Retinal fundus photograph: 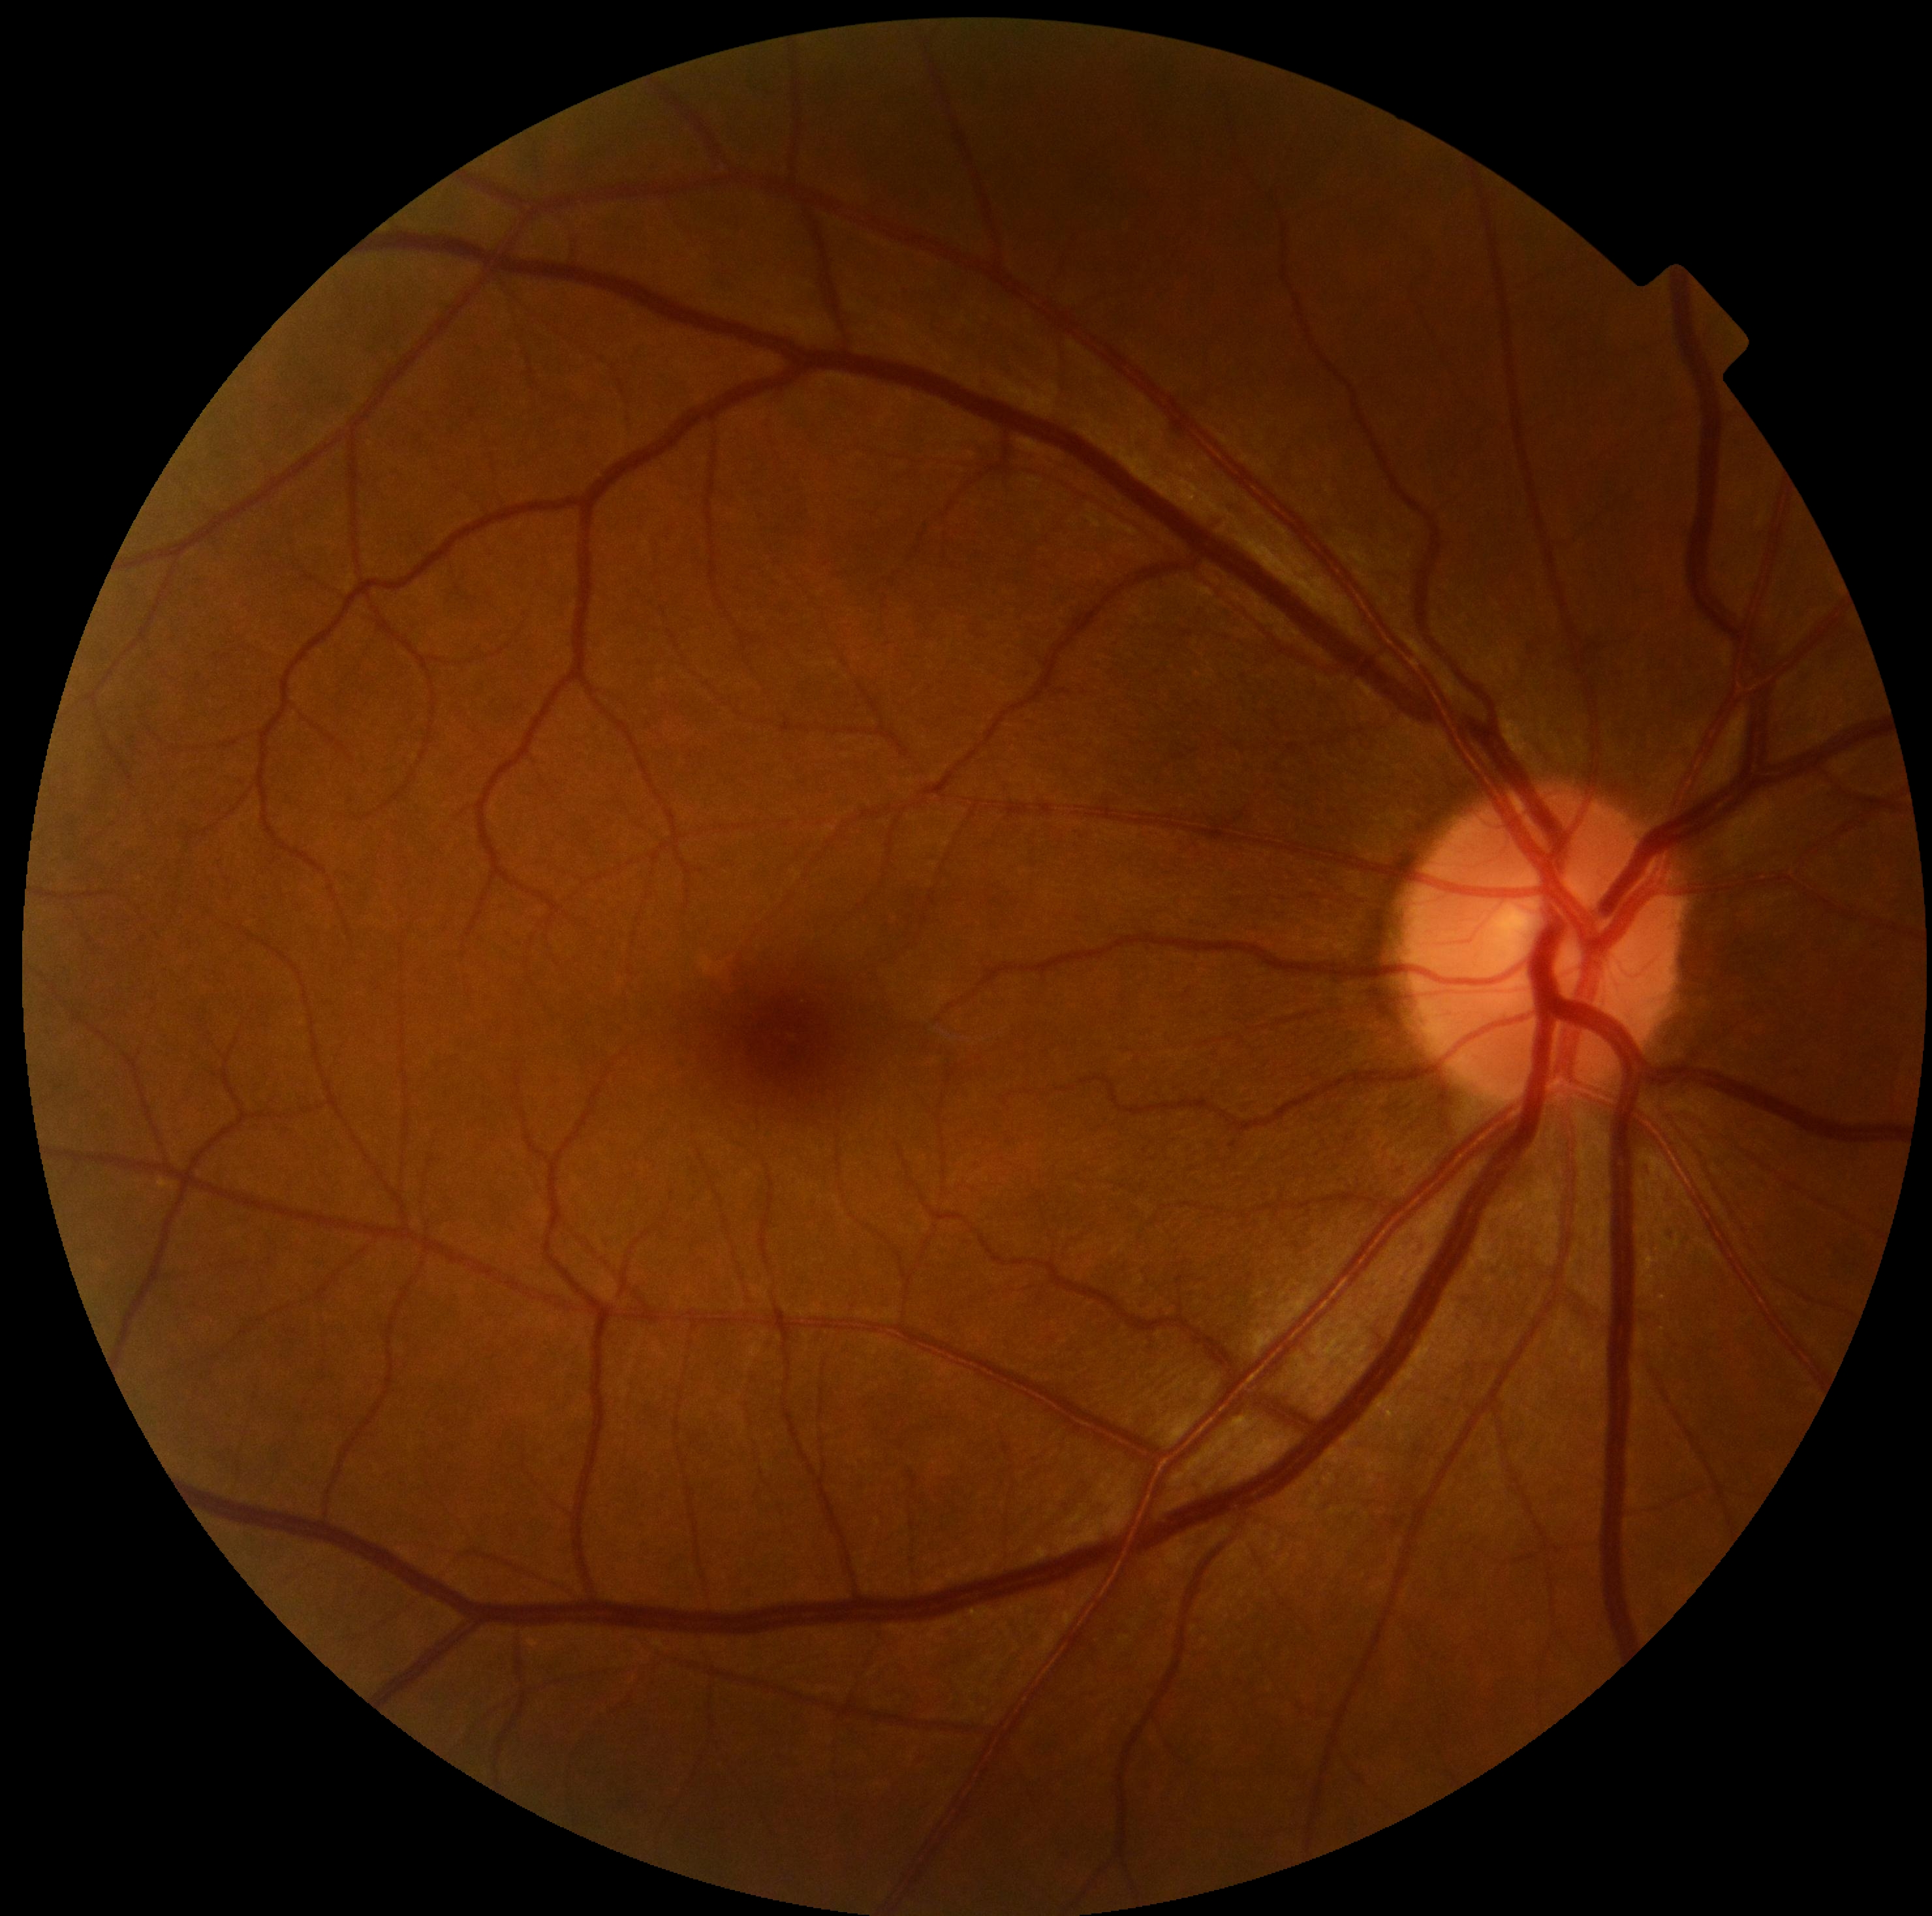

Diabetic retinopathy (DR): grade 0 (no apparent retinopathy) — no visible signs of diabetic retinopathy. No diabetic retinal disease findings.